Wide-field fundus image from infant ROP screening · image size 640x480 · camera: Clarity RetCam 3 (130° FOV) — 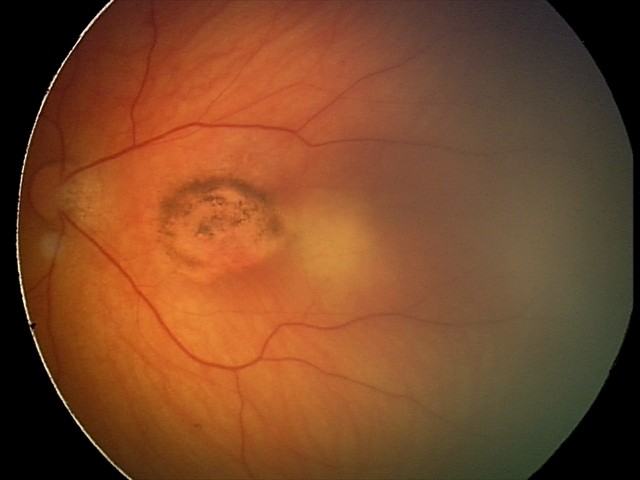 Finding: toxoplasmosis chorioretinitis.